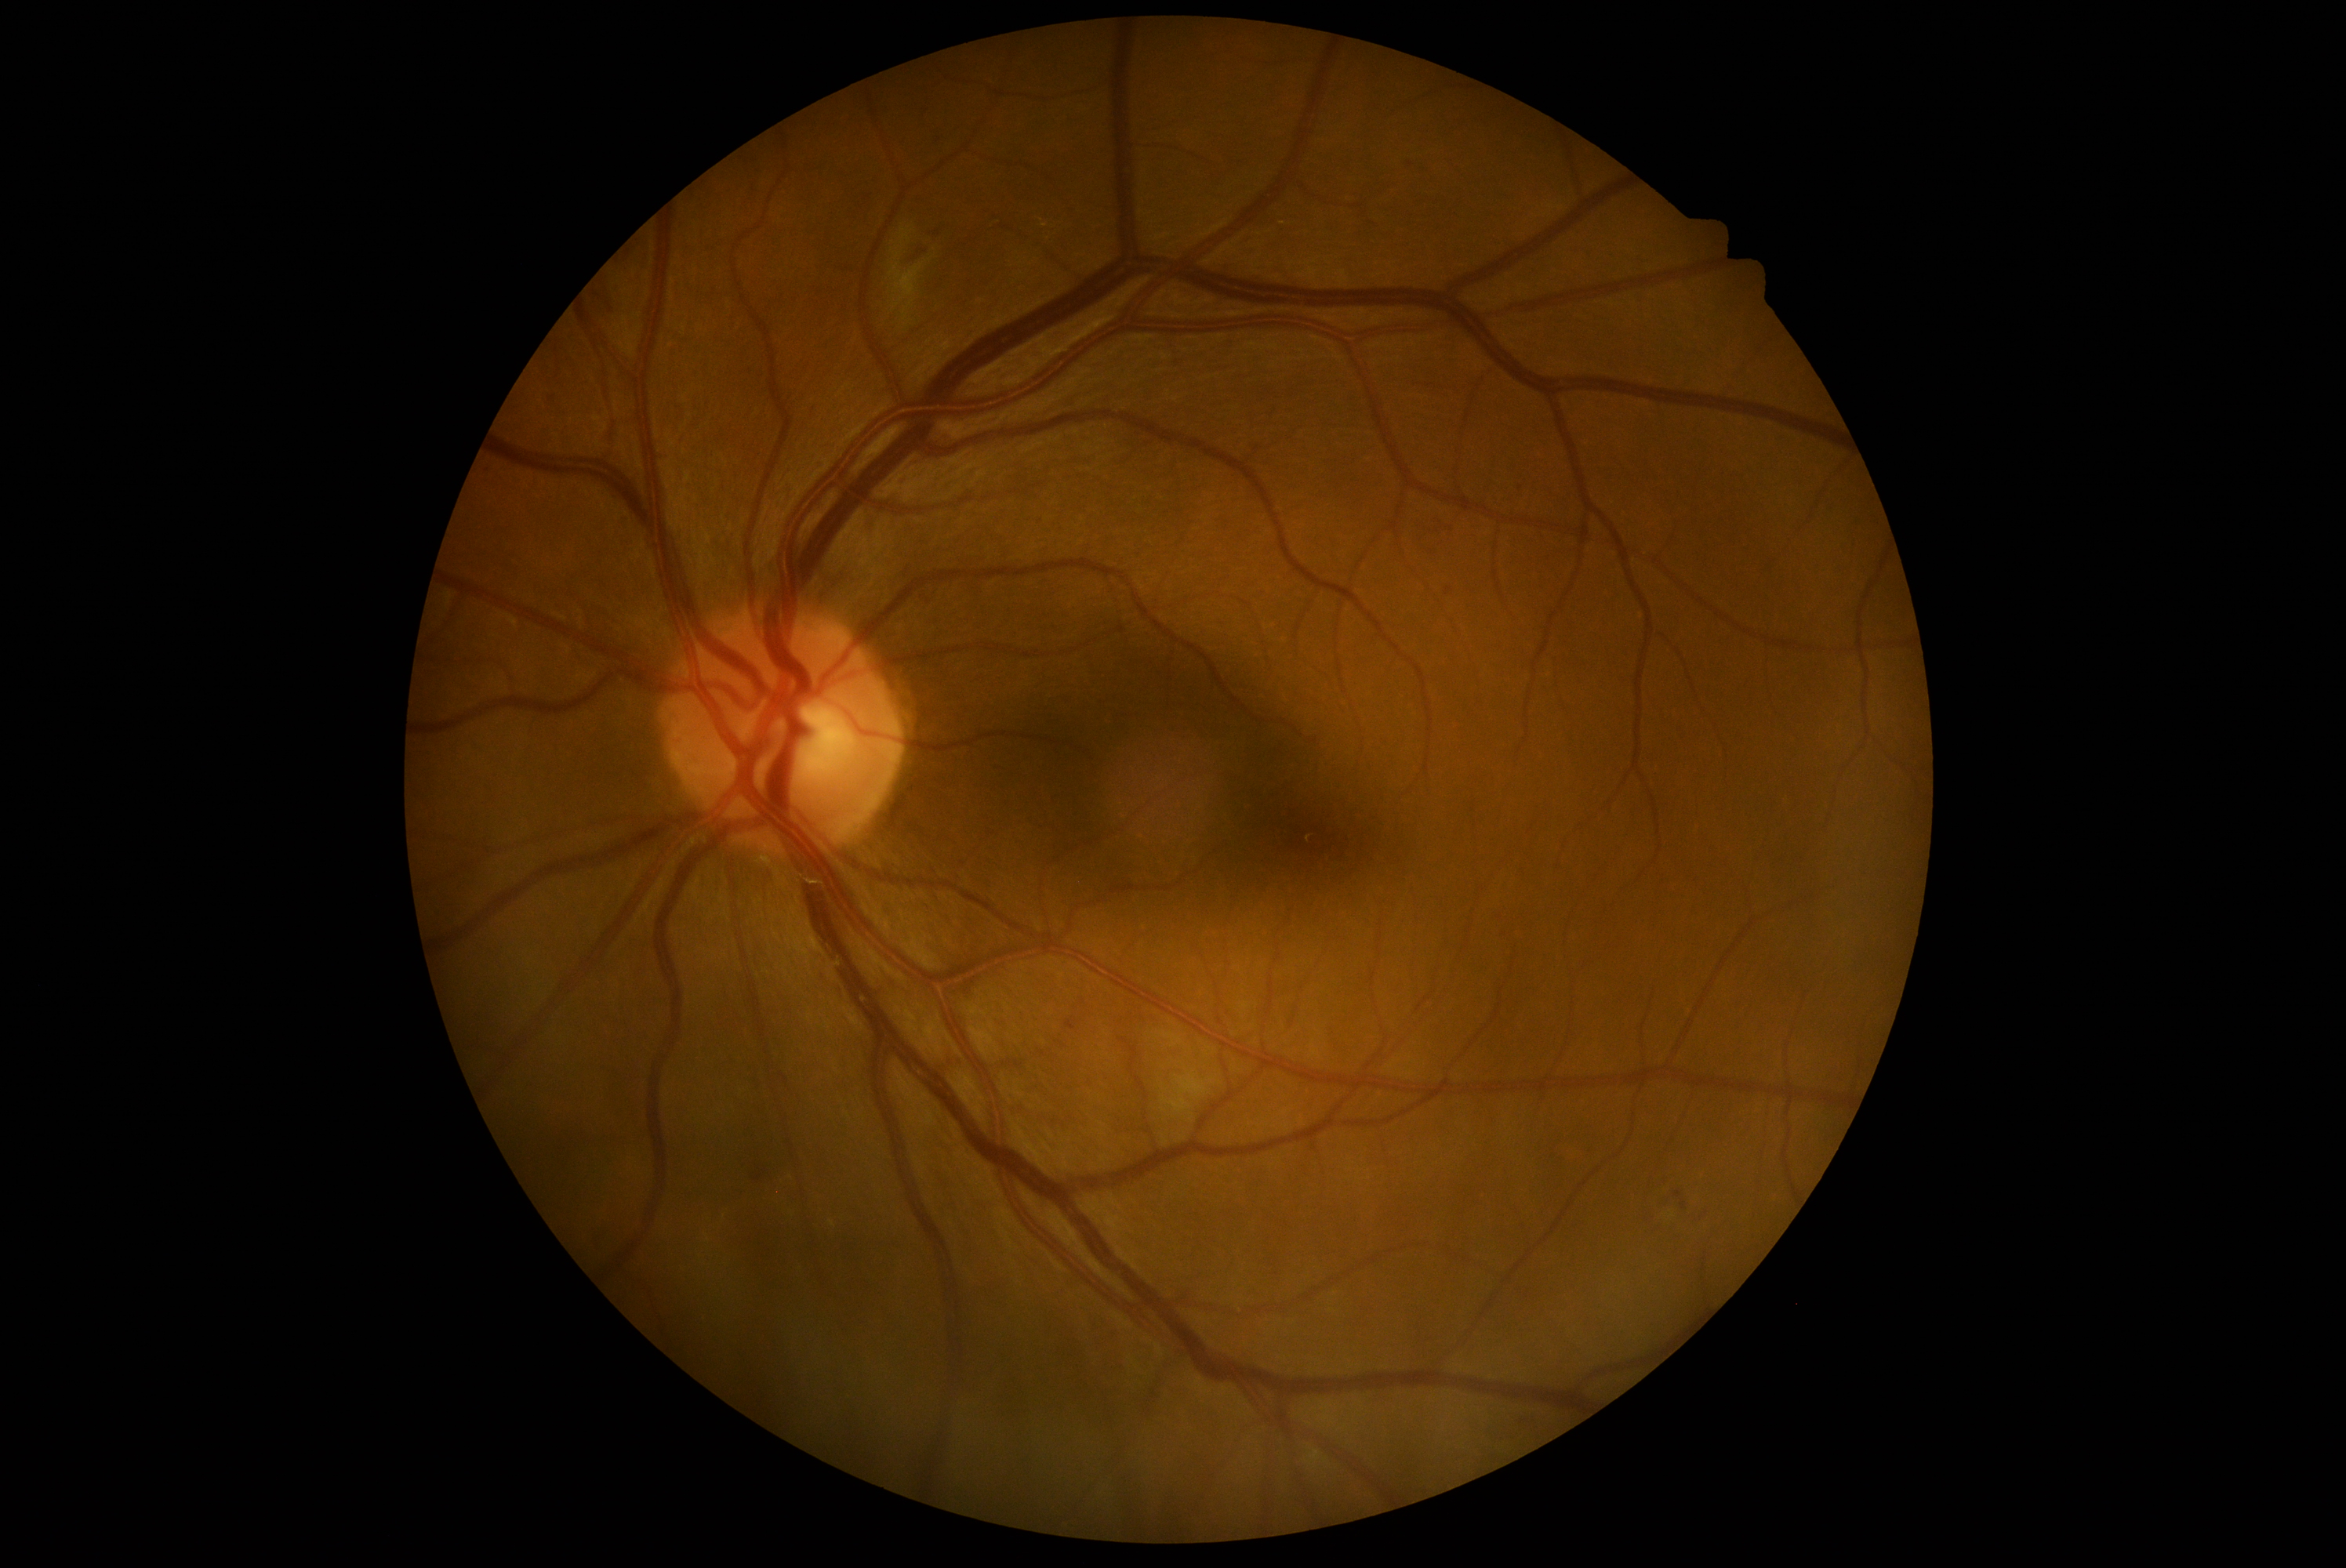

Diabetic retinopathy grade: 2 (moderate NPDR). DR class: non-proliferative diabetic retinopathy.